FOV: 45 degrees.
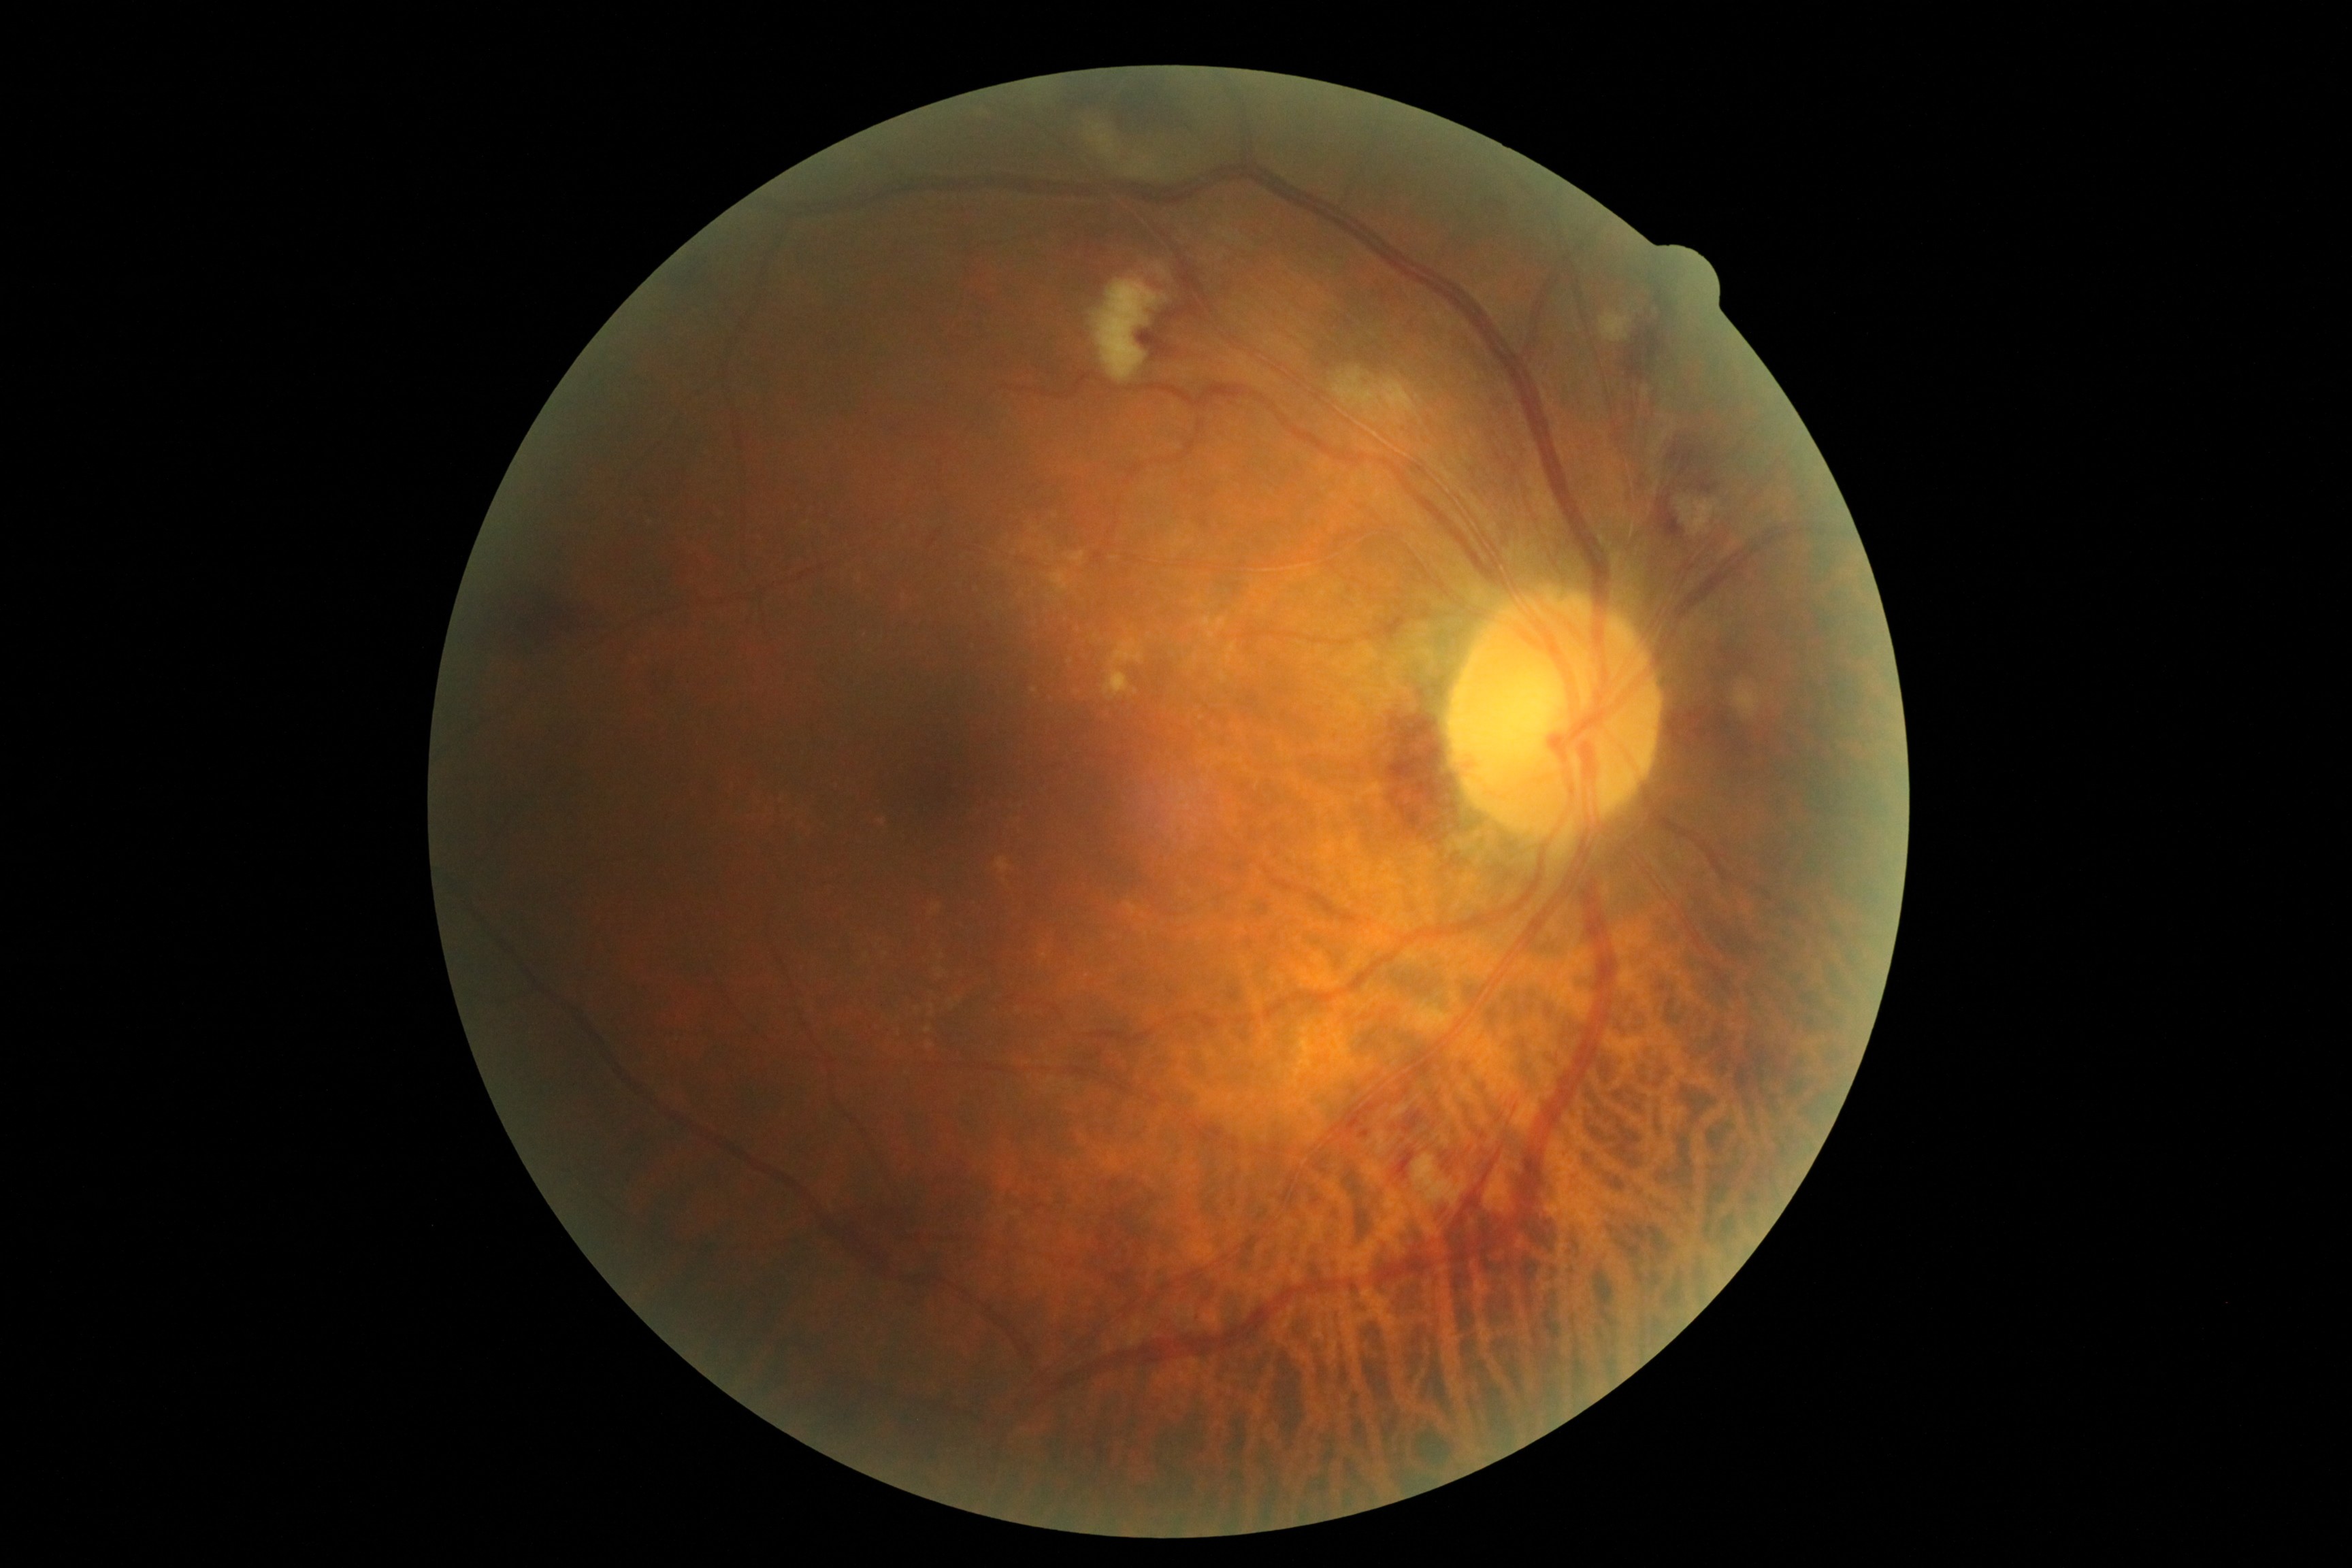

Diabetic retinopathy grade: 2/4.